Image size 2102x1736. Color fundus photograph:
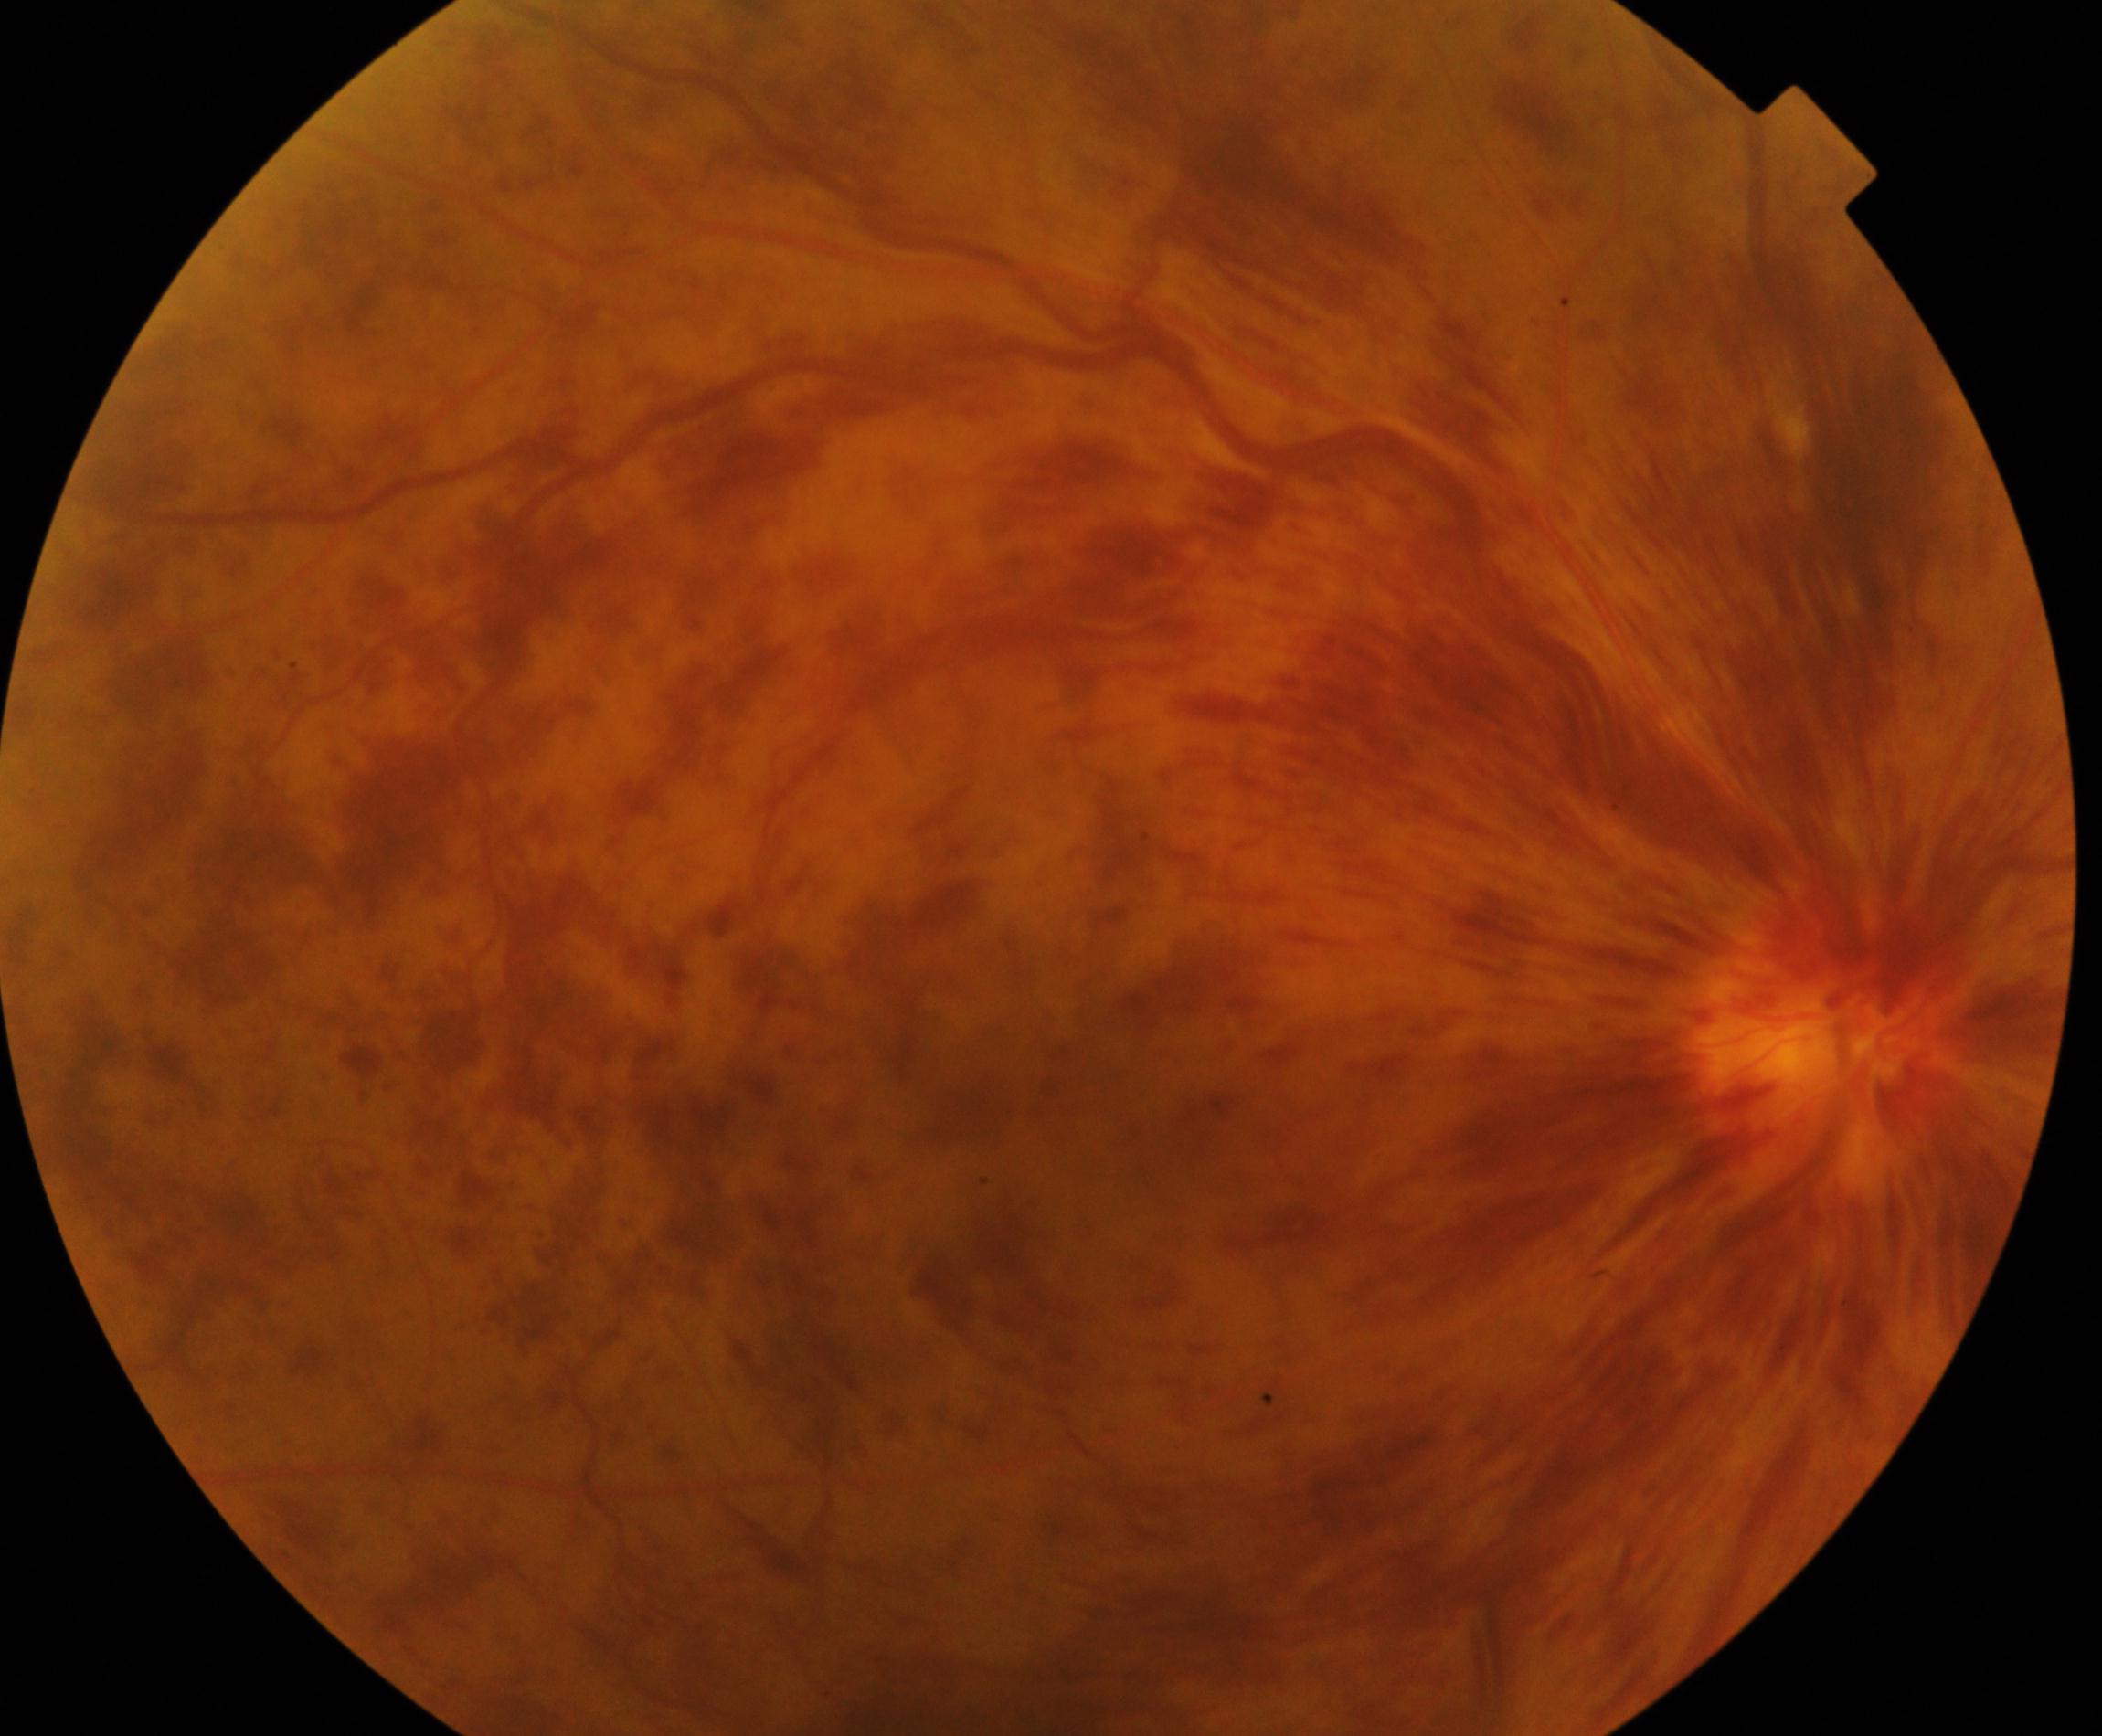

Findings: central retinal vein occlusion.